FOV: 45 degrees; retinal fundus photograph
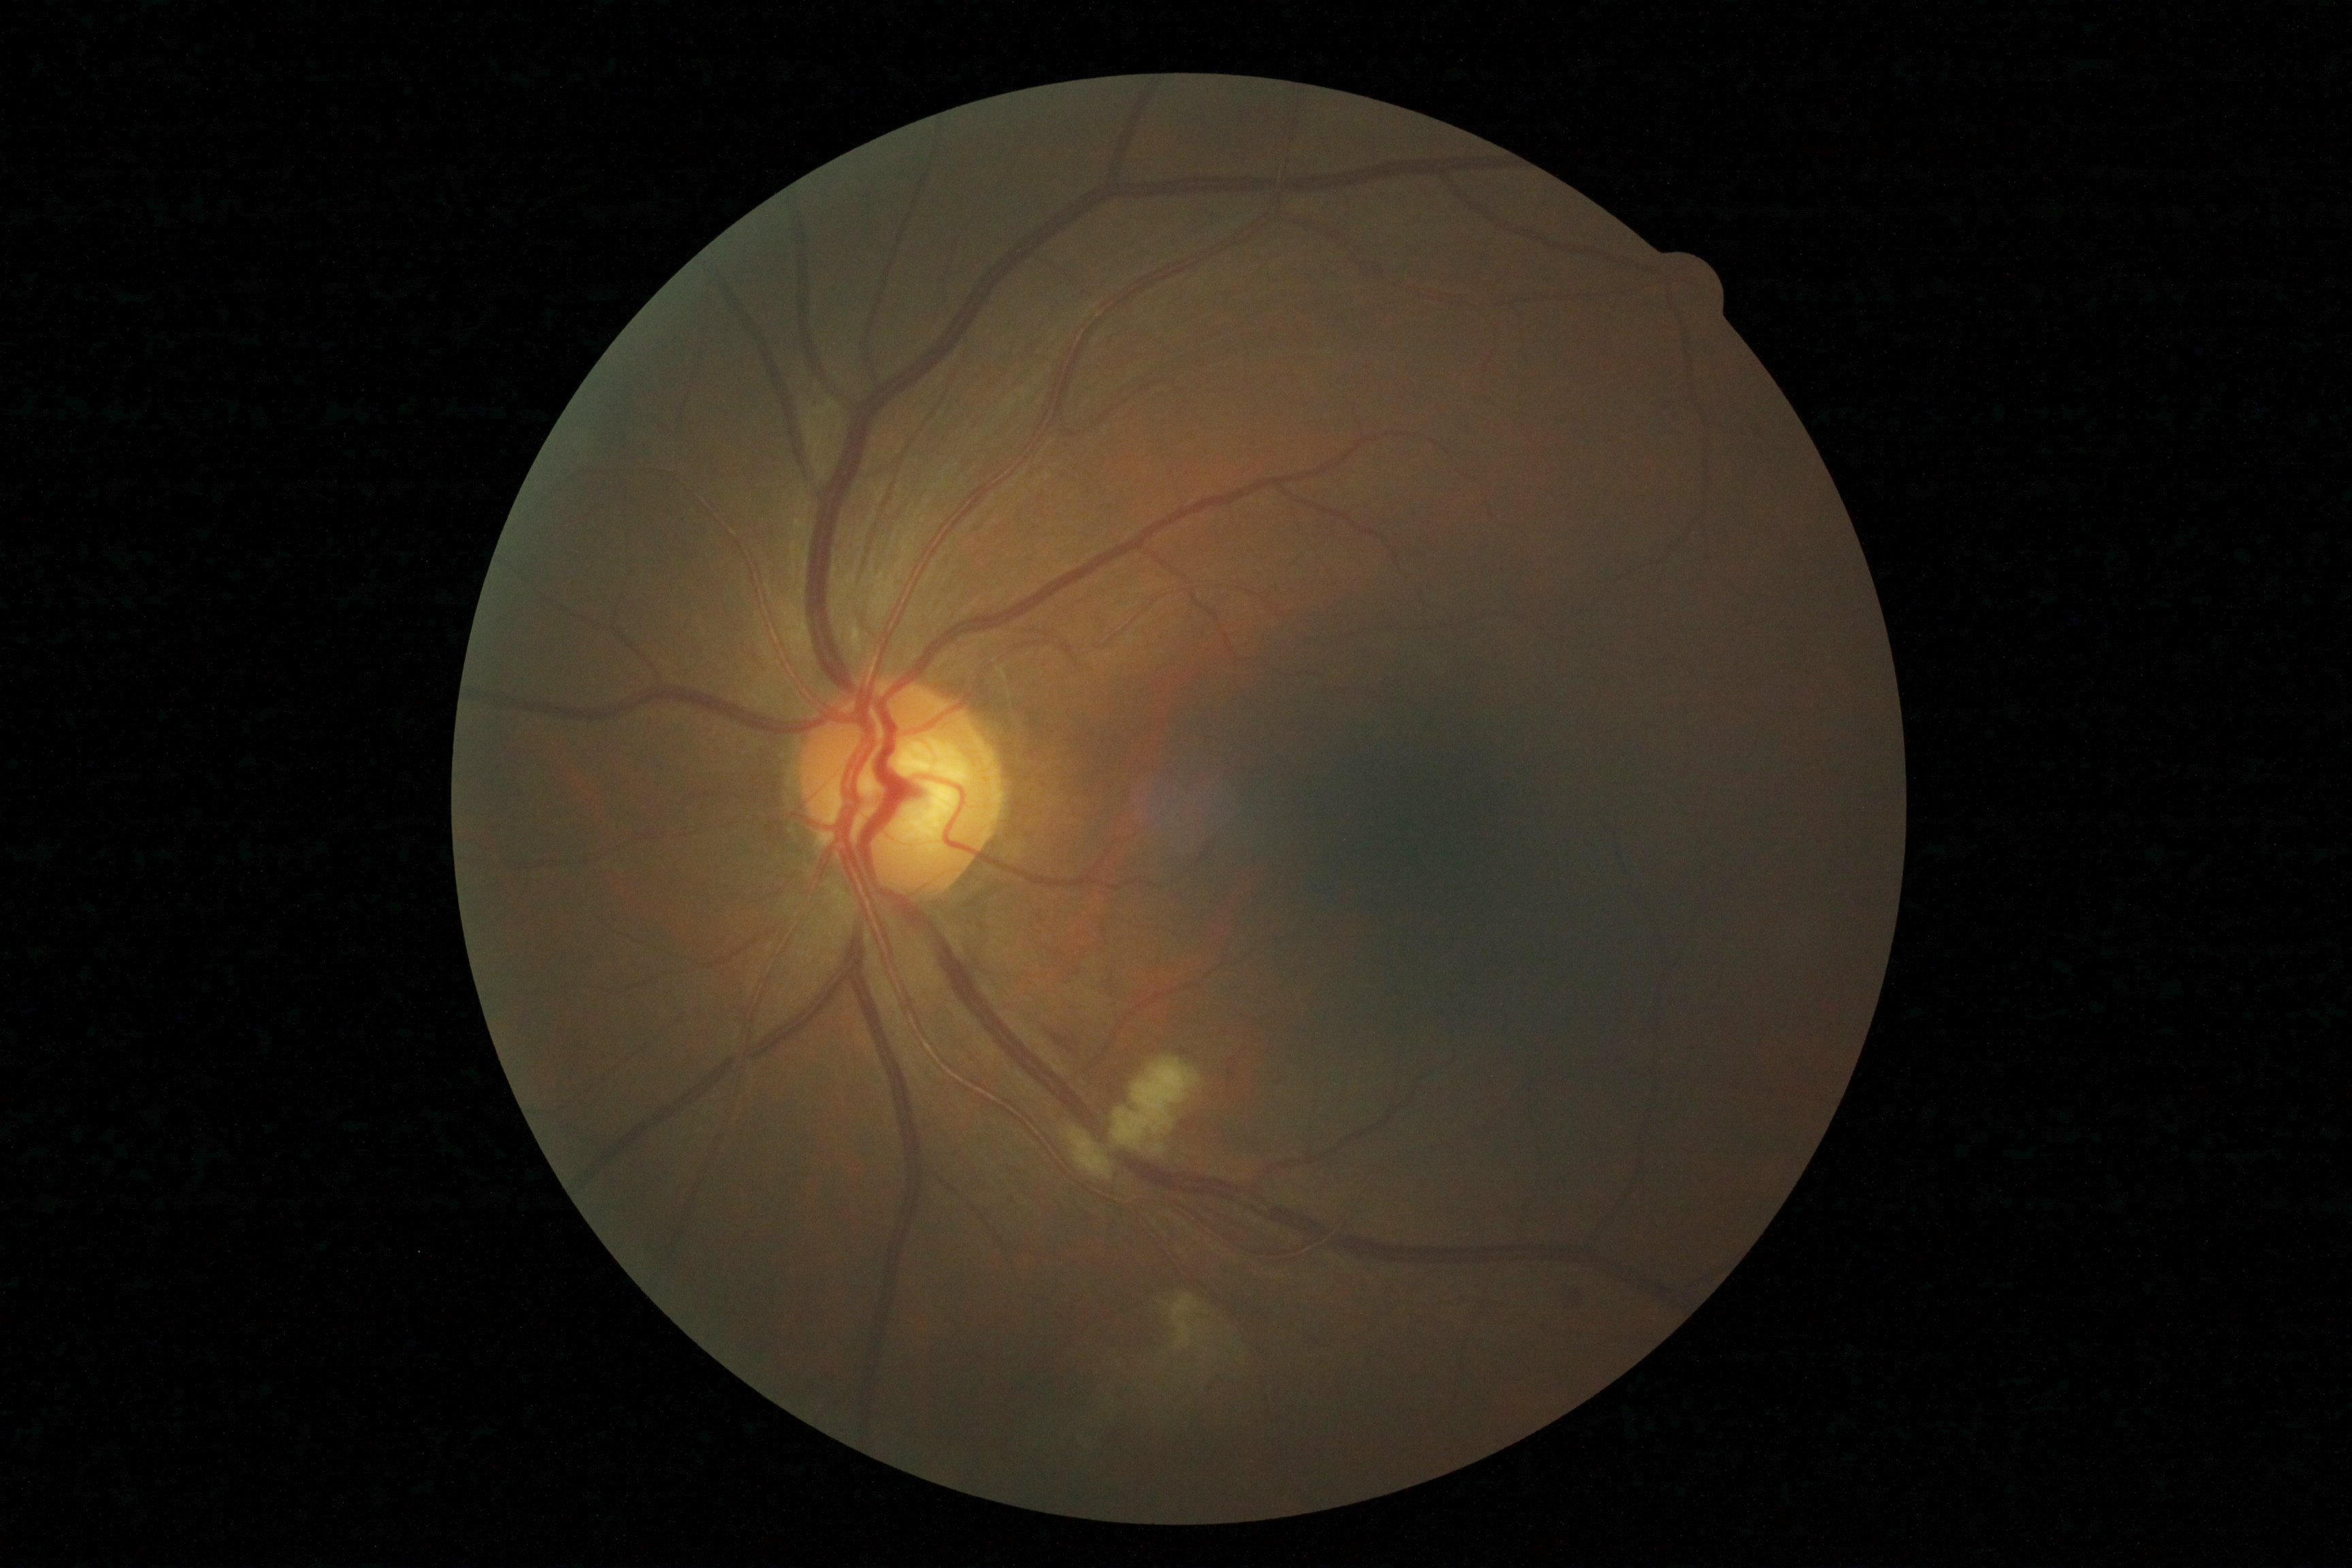 DR: grade 2 (moderate NPDR).